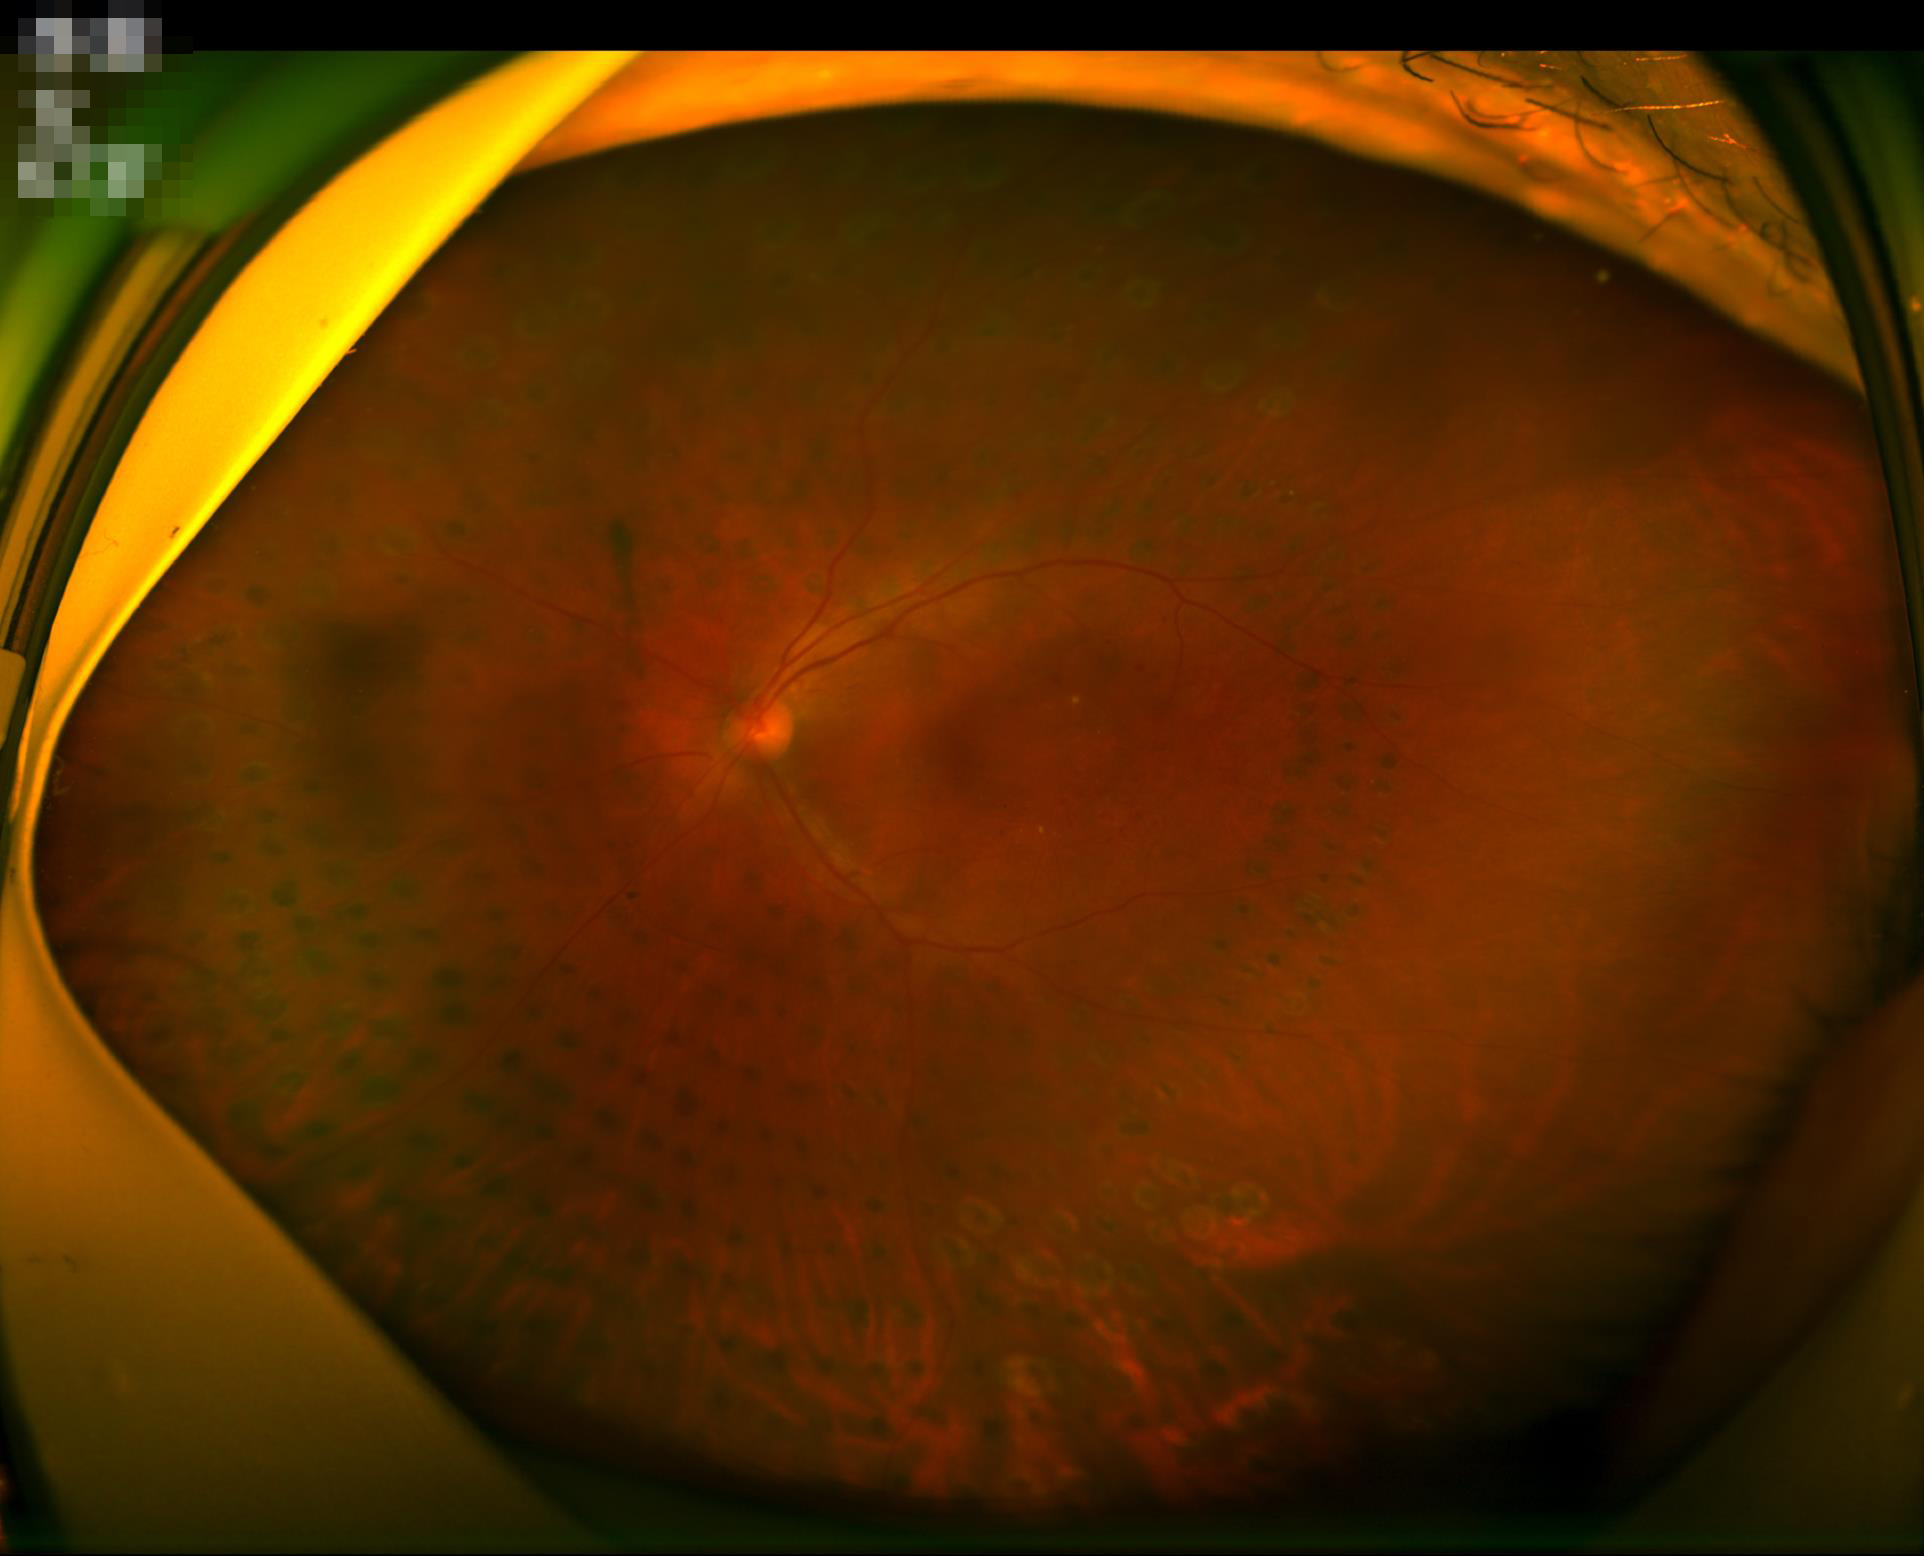 Overall image quality is poor. Narrow intensity range; structures are hard to distinguish. Optic disc, vessels, and background are in focus. Poor illumination with uneven exposure.